512 x 512 pixels · fundus photo: 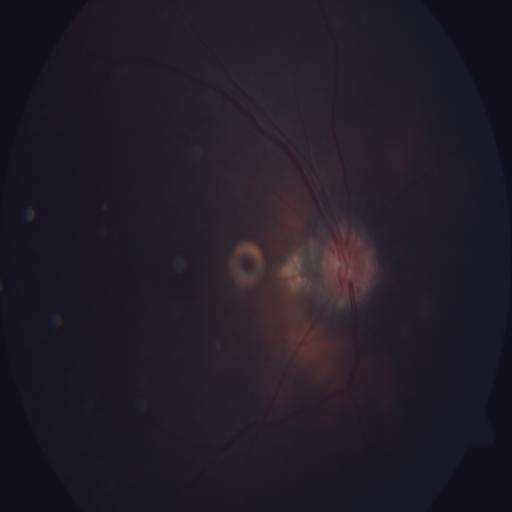 The image shows optic disc edema.